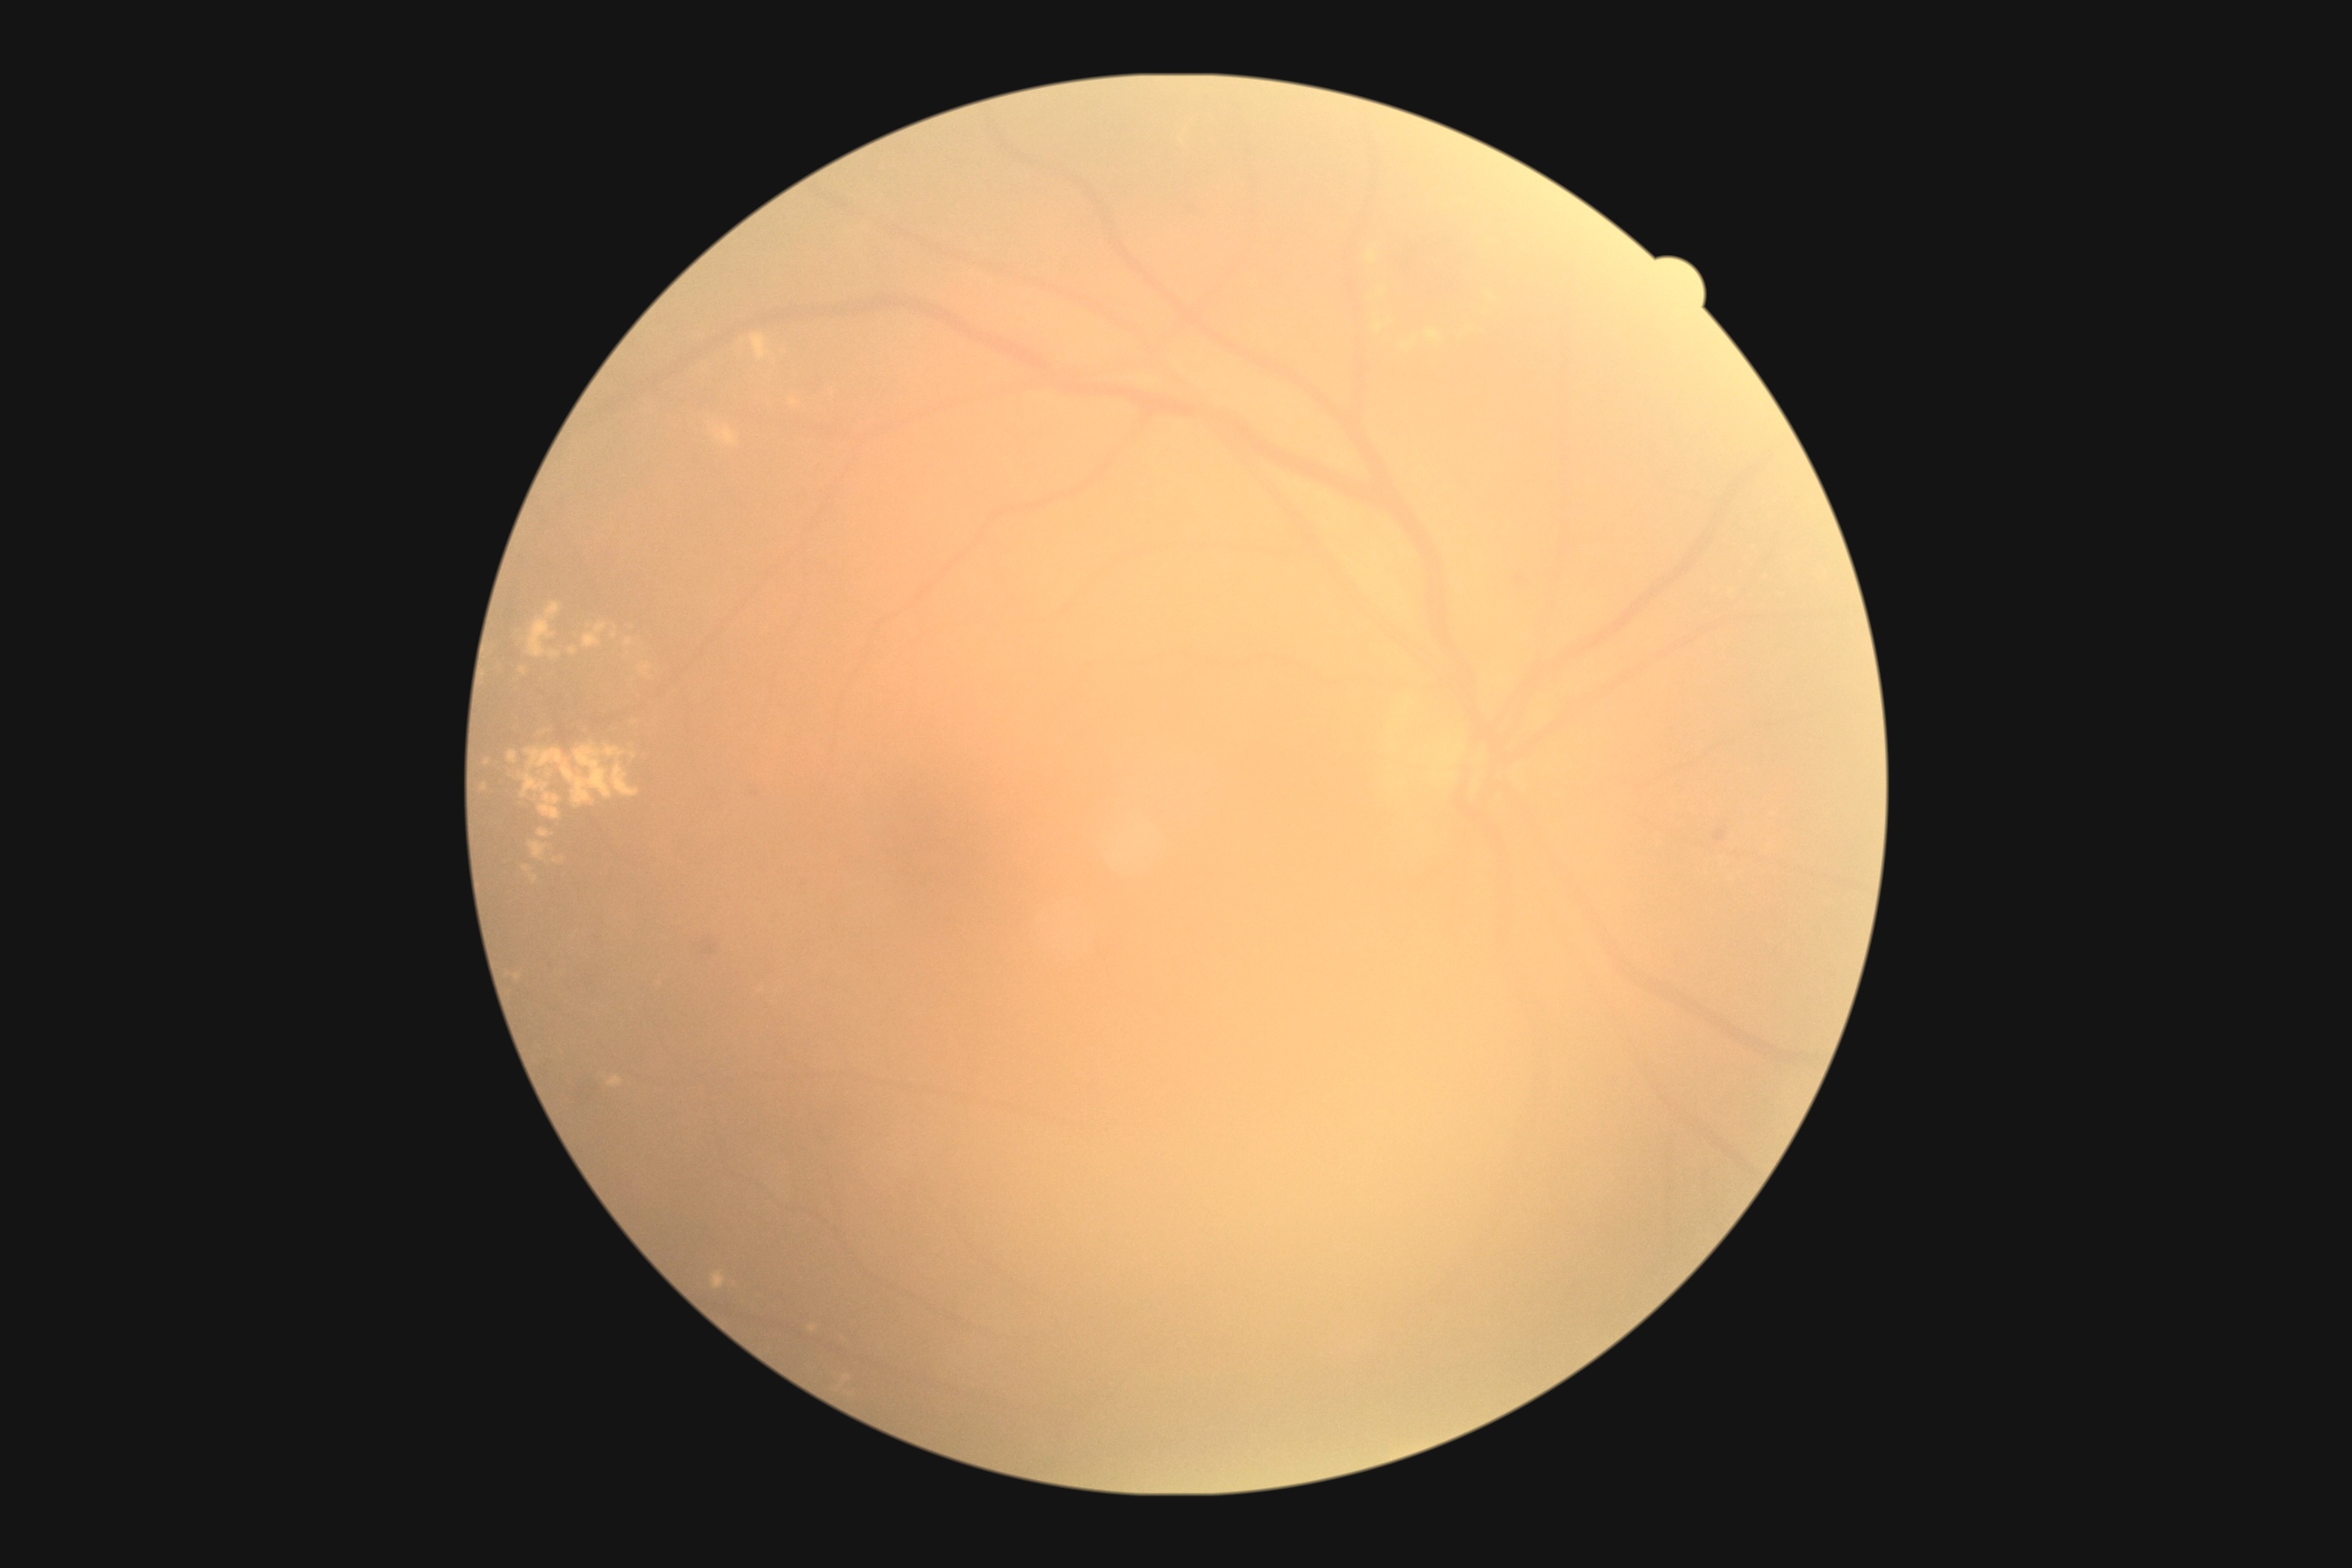
DR is grade 2 (moderate NPDR) — more than just microaneurysms but less than severe NPDR.